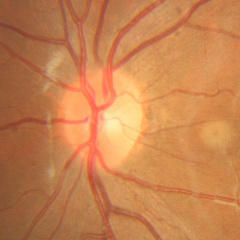
Glaucoma stage = no glaucoma.